Captured with the Phoenix ICON (100° field of view) · Phoenix ICON wide-field infant fundus image
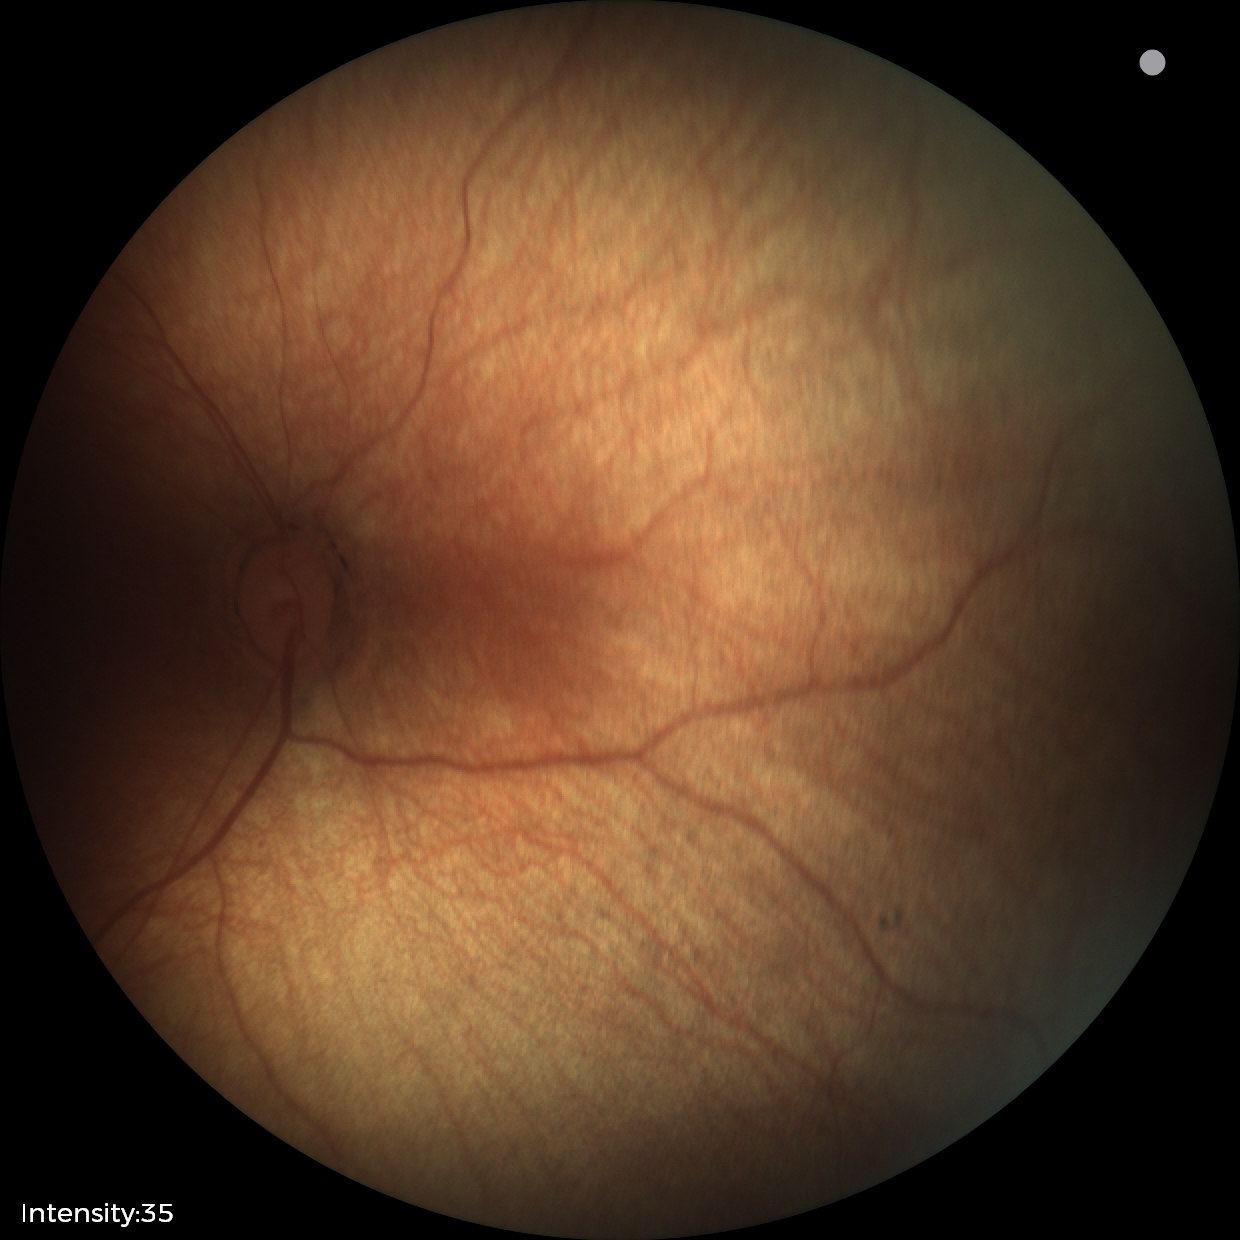

Normal screening examination.